45° FOV.
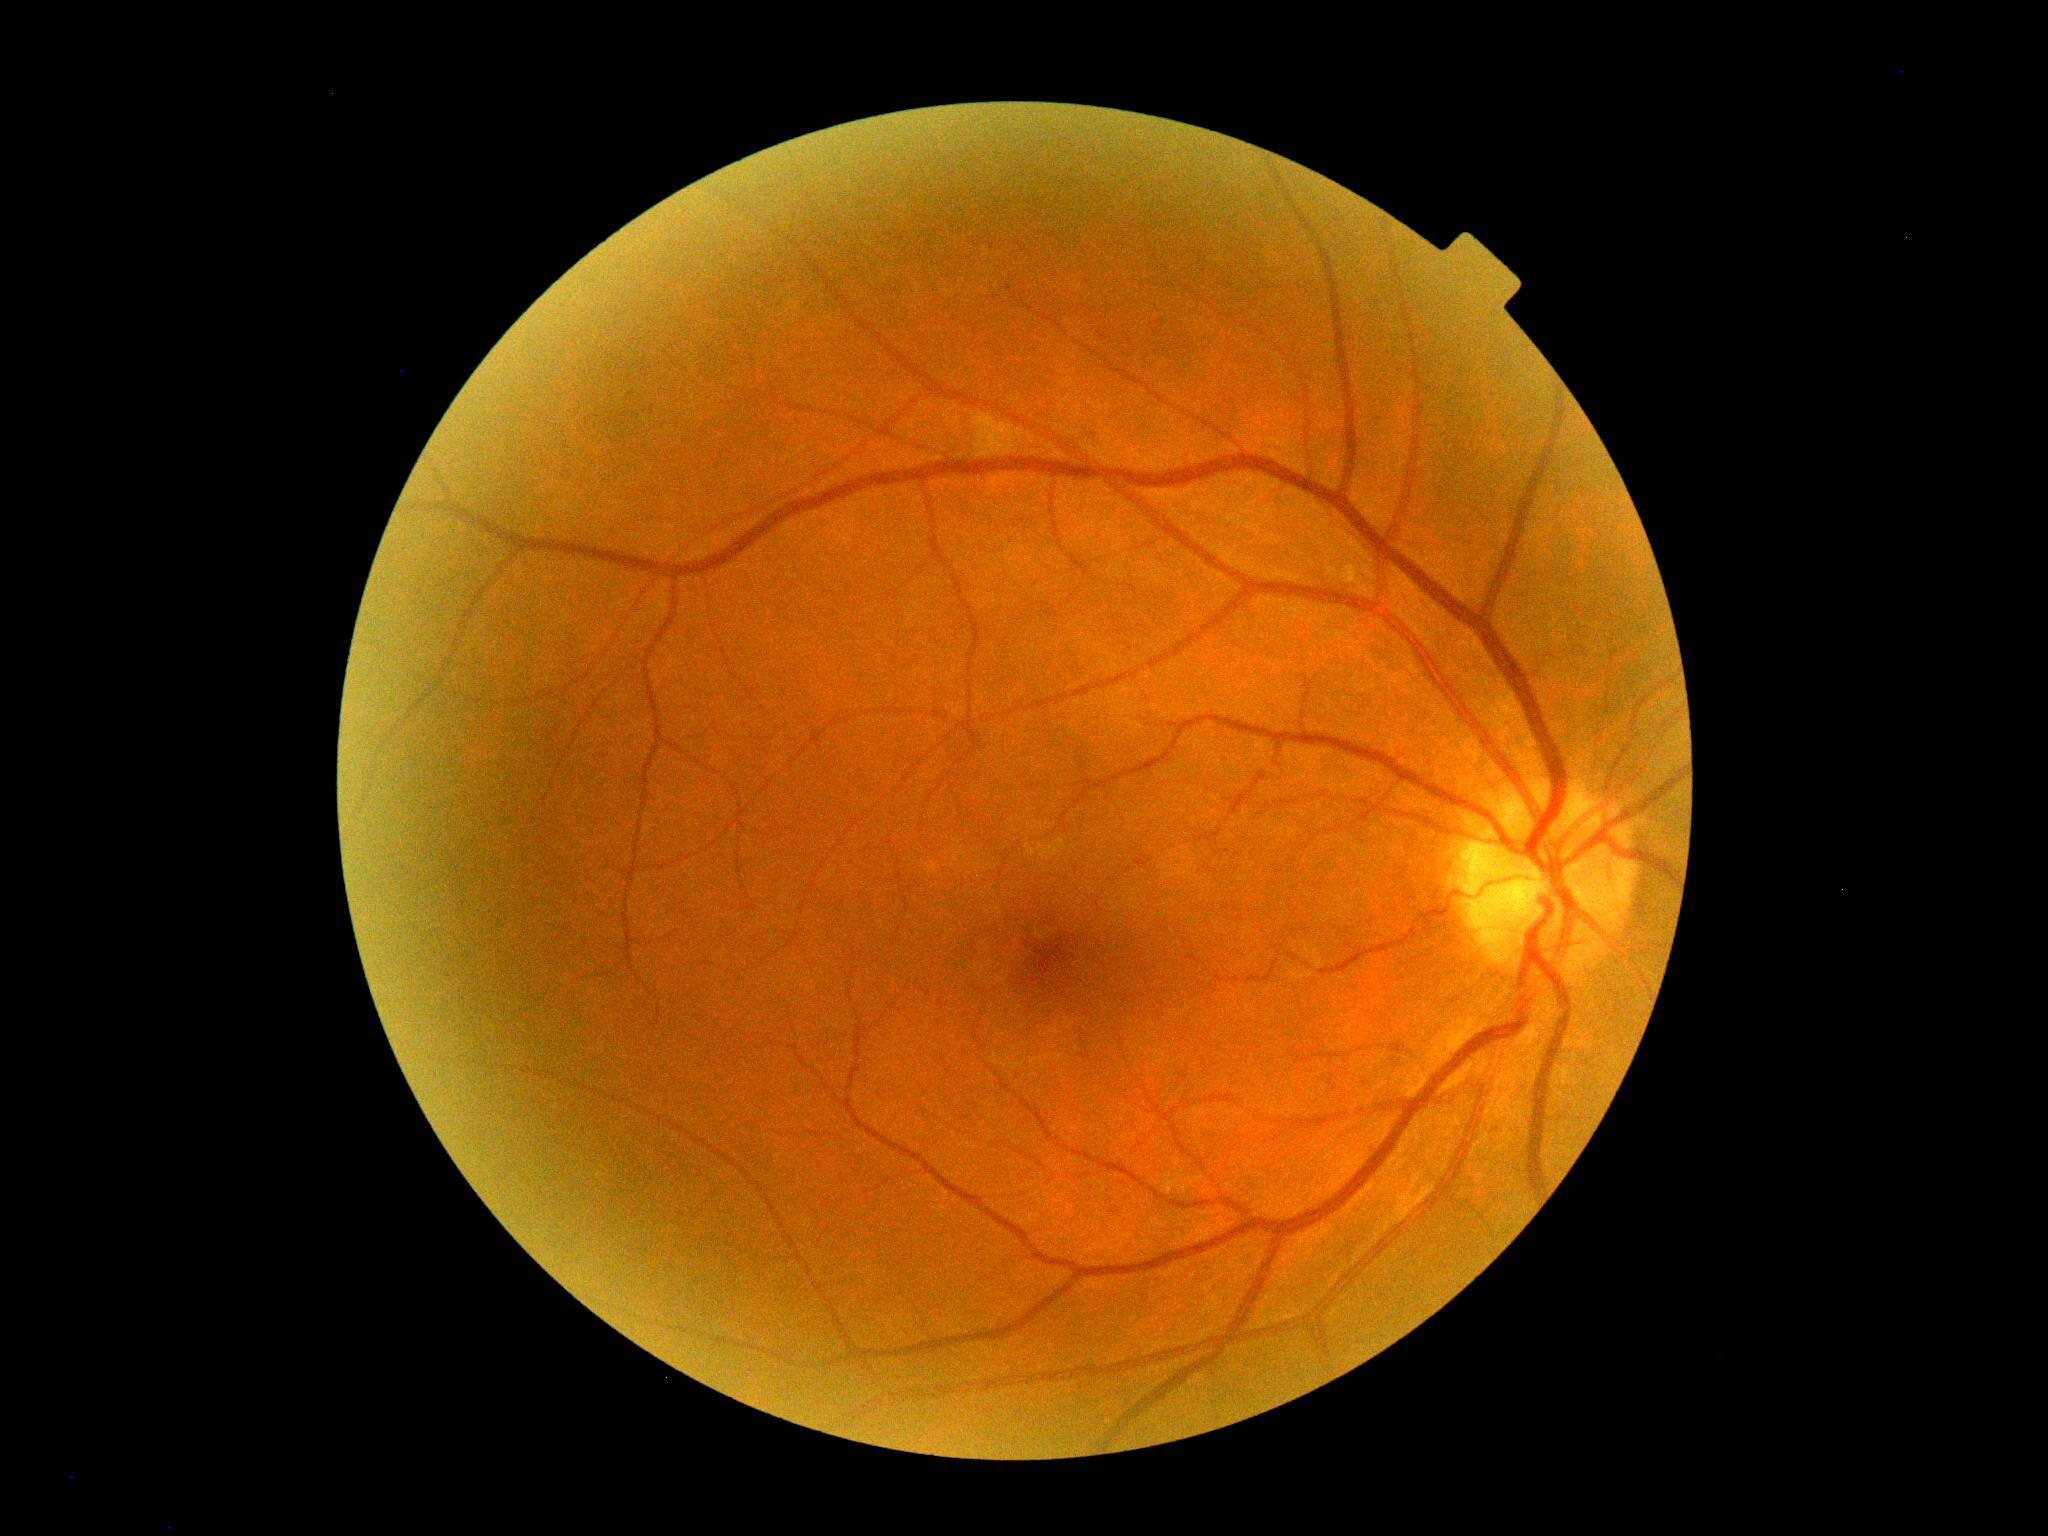
Diabetic retinopathy is grade 0. No signs of diabetic retinopathy.